45° FOV
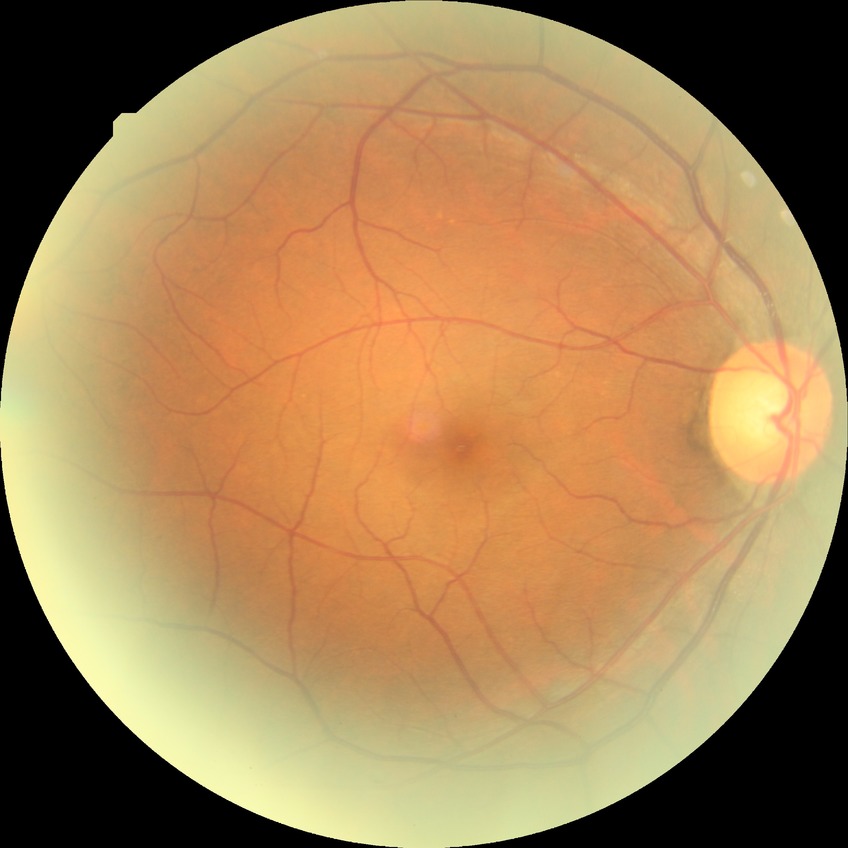
{"davis_grade": "NDR (no diabetic retinopathy)"}